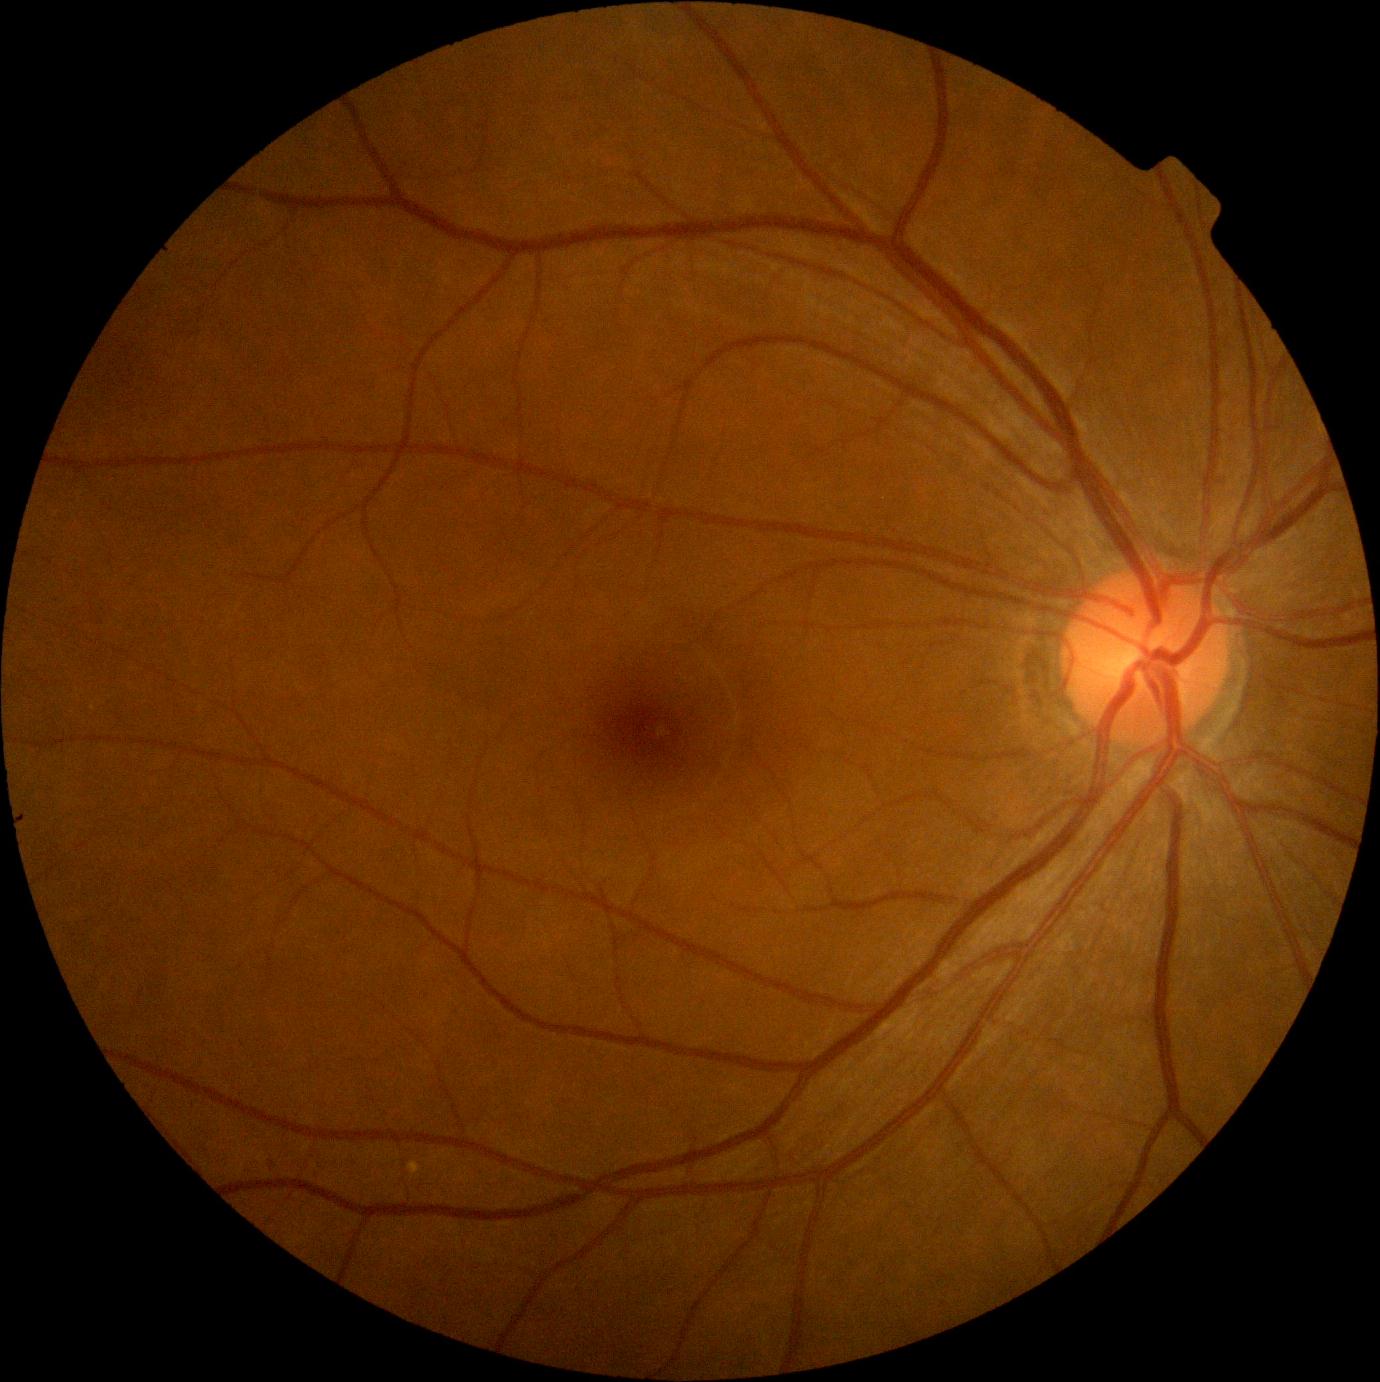
Findings:
– DR — mild non-proliferative diabetic retinopathy (grade 1)